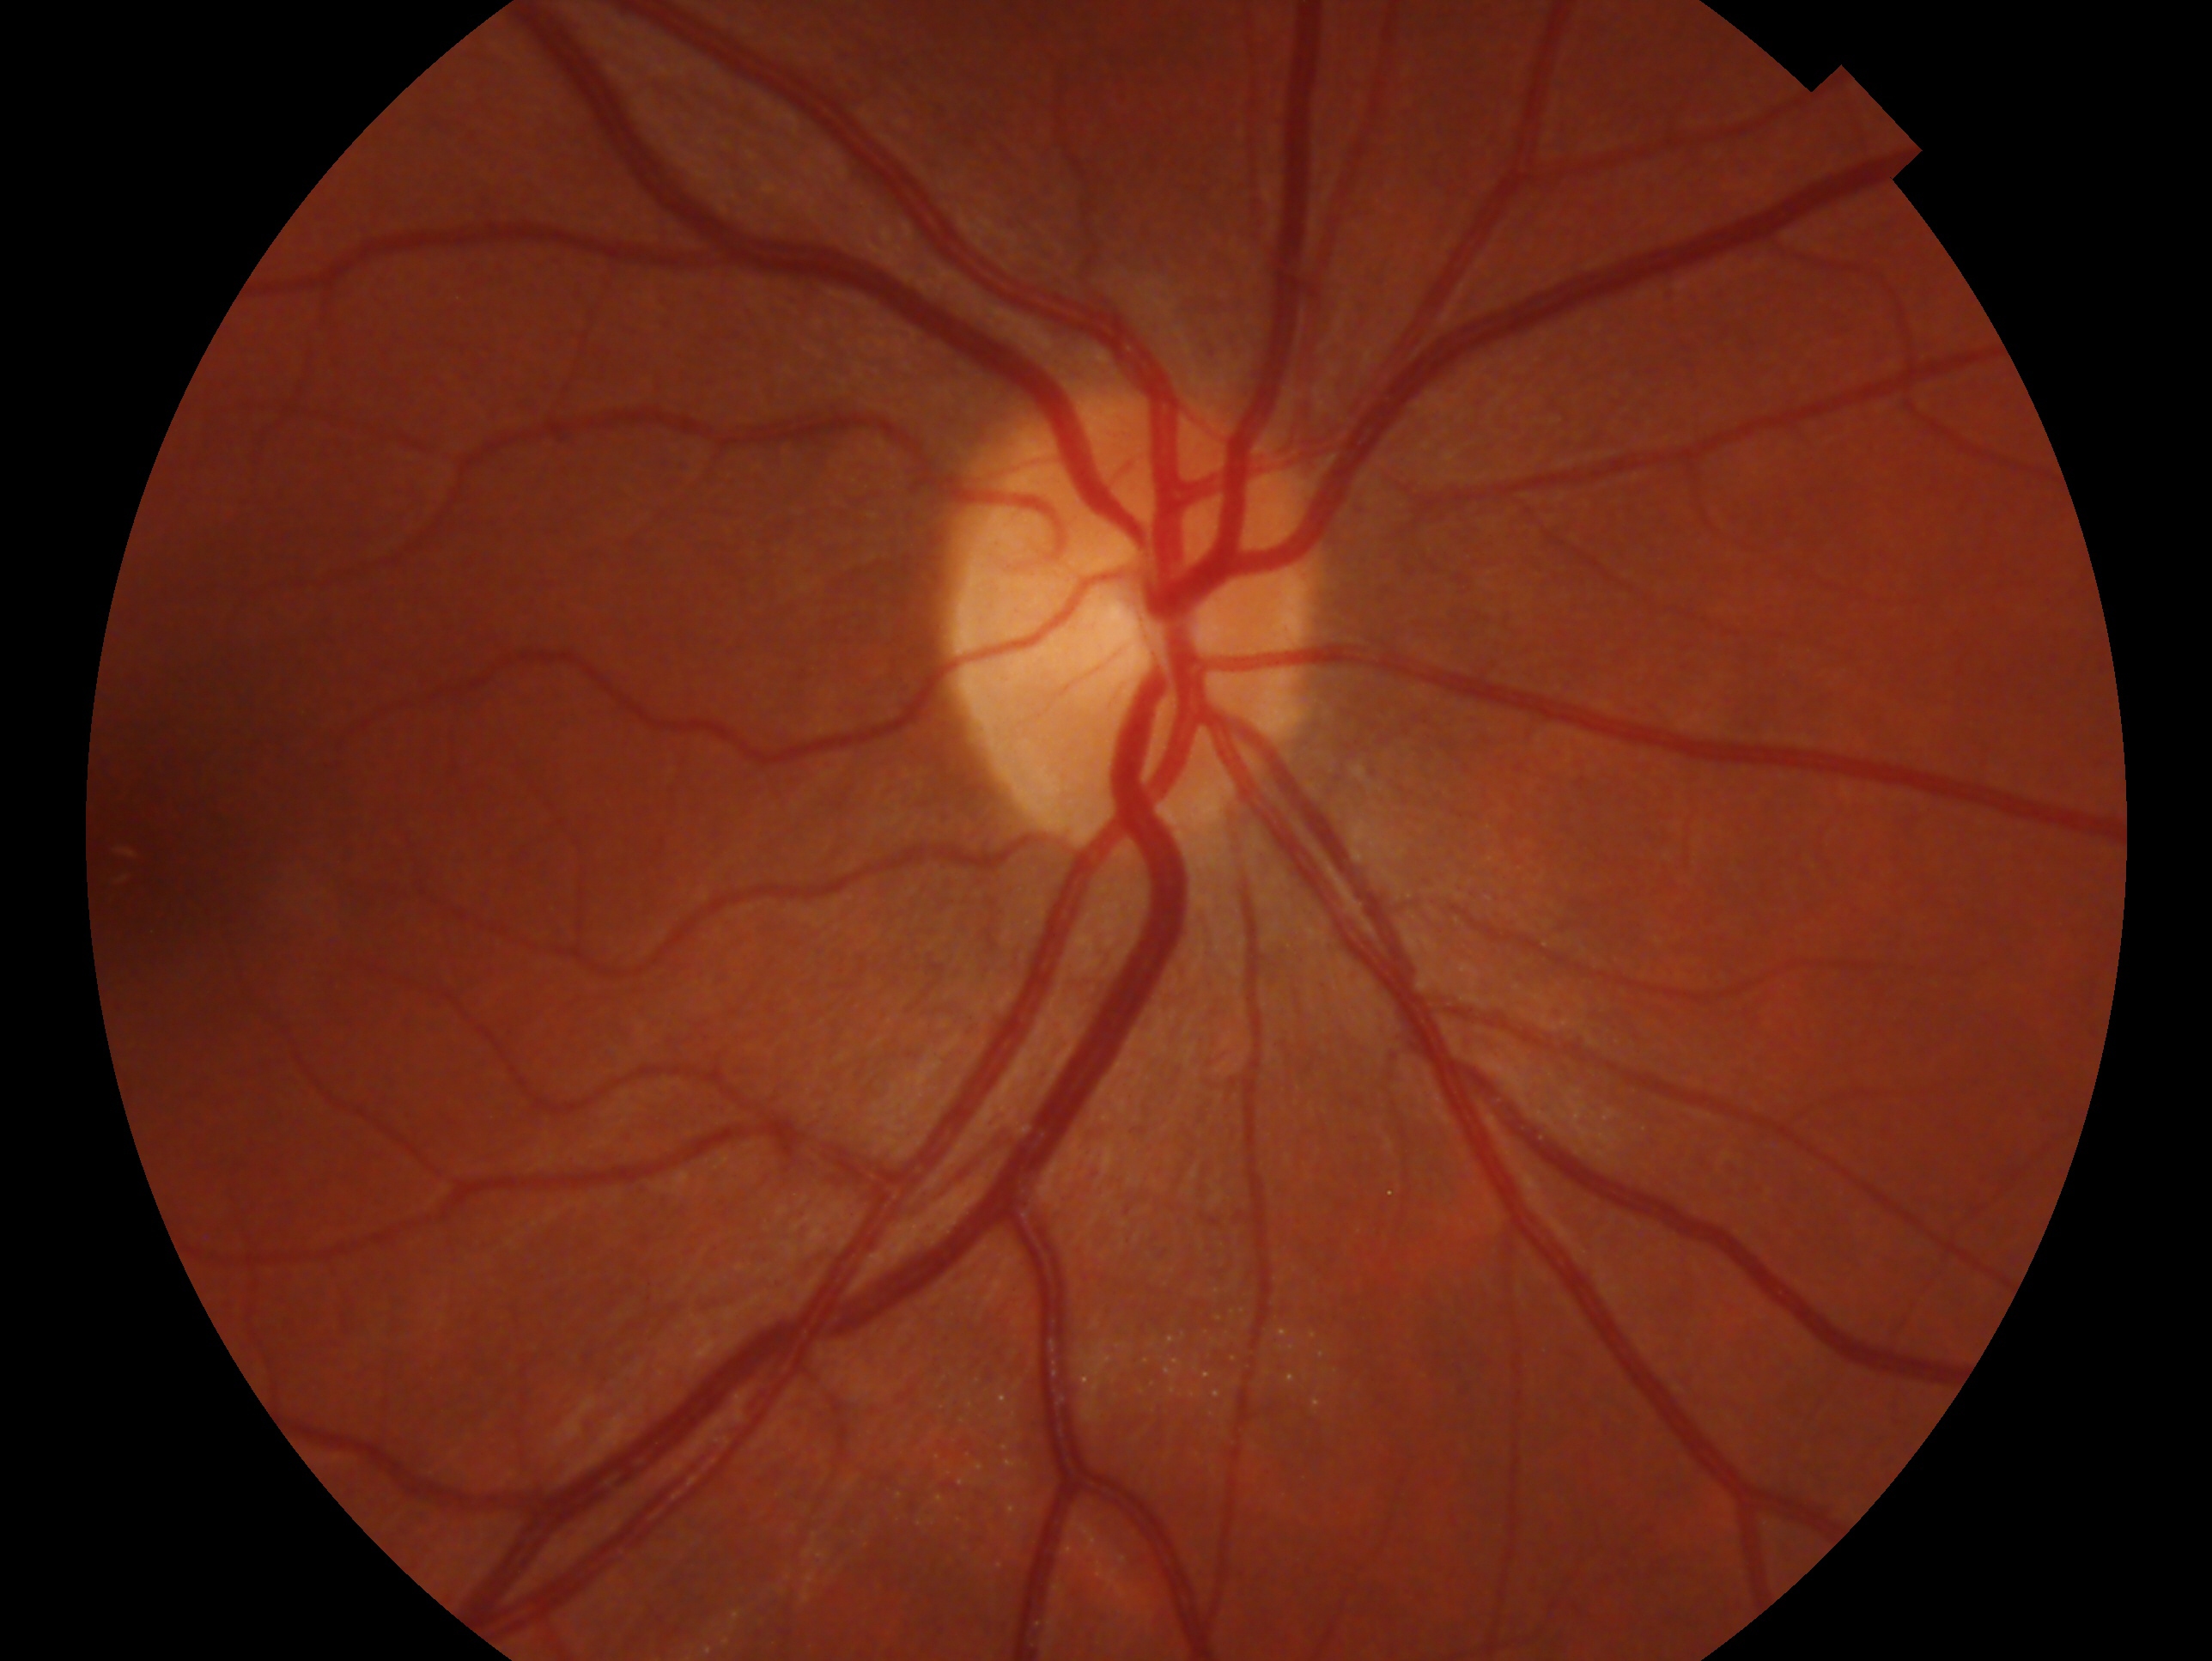

Impression: no evidence of glaucoma.
Imaged eye: right eye.